45° field of view. 1380 x 1382 pixels
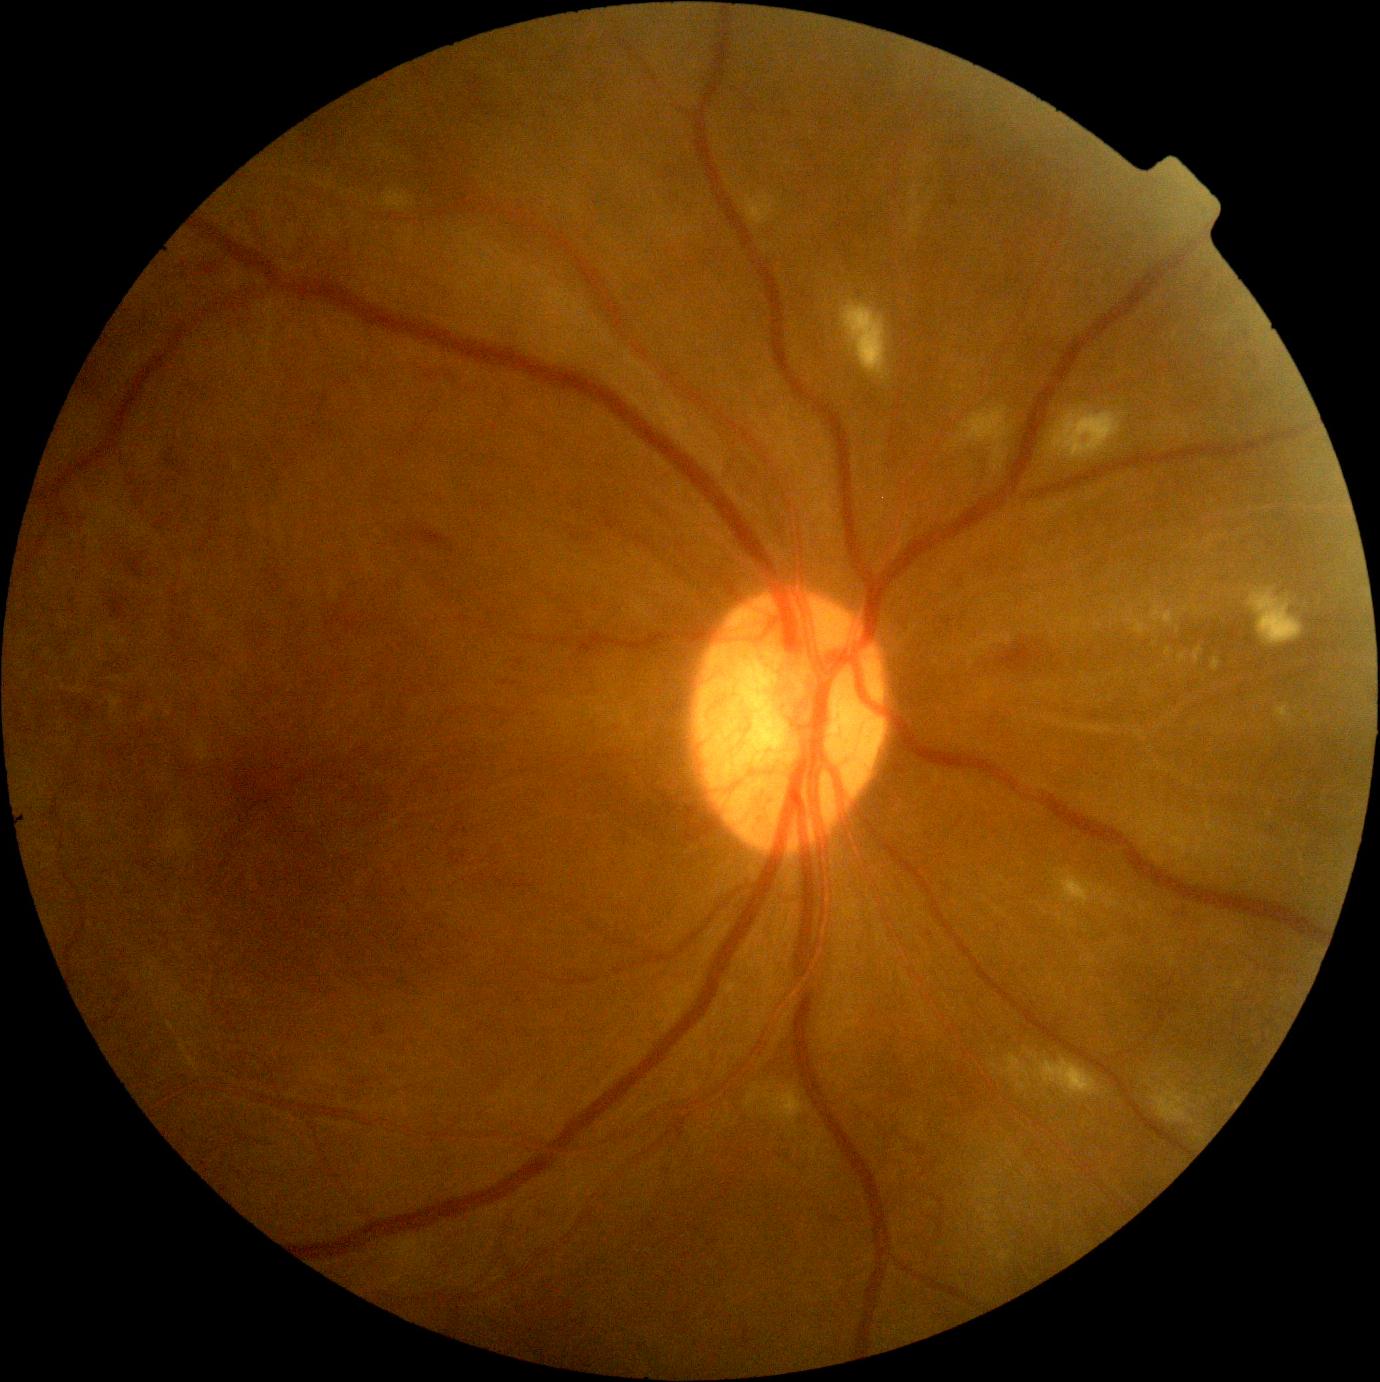

{"dr_grade": 4, "lesions": {"se": [[777, 1094, 793, 1121], [1065, 879, 1087, 902], [956, 407, 1013, 474], [1248, 588, 1303, 646], [745, 193, 779, 225], [842, 301, 890, 380], [1052, 406, 1127, 459], [1062, 1062, 1103, 1094], [381, 192, 410, 213], [1151, 1081, 1197, 1124]], "ma": null, "he": [[106, 595, 126, 619], [166, 447, 180, 470], [1003, 645, 1034, 670], [410, 528, 446, 549], [375, 1021, 387, 1035], [130, 560, 141, 578]], "ex": [[1151, 602, 1182, 626], [1211, 657, 1221, 672], [1192, 646, 1204, 664], [1070, 886, 1091, 902], [1178, 653, 1188, 664], [1278, 709, 1286, 720], [1129, 619, 1150, 636]], "ex_small_approx": [[1168, 651], [1179, 629]]}}